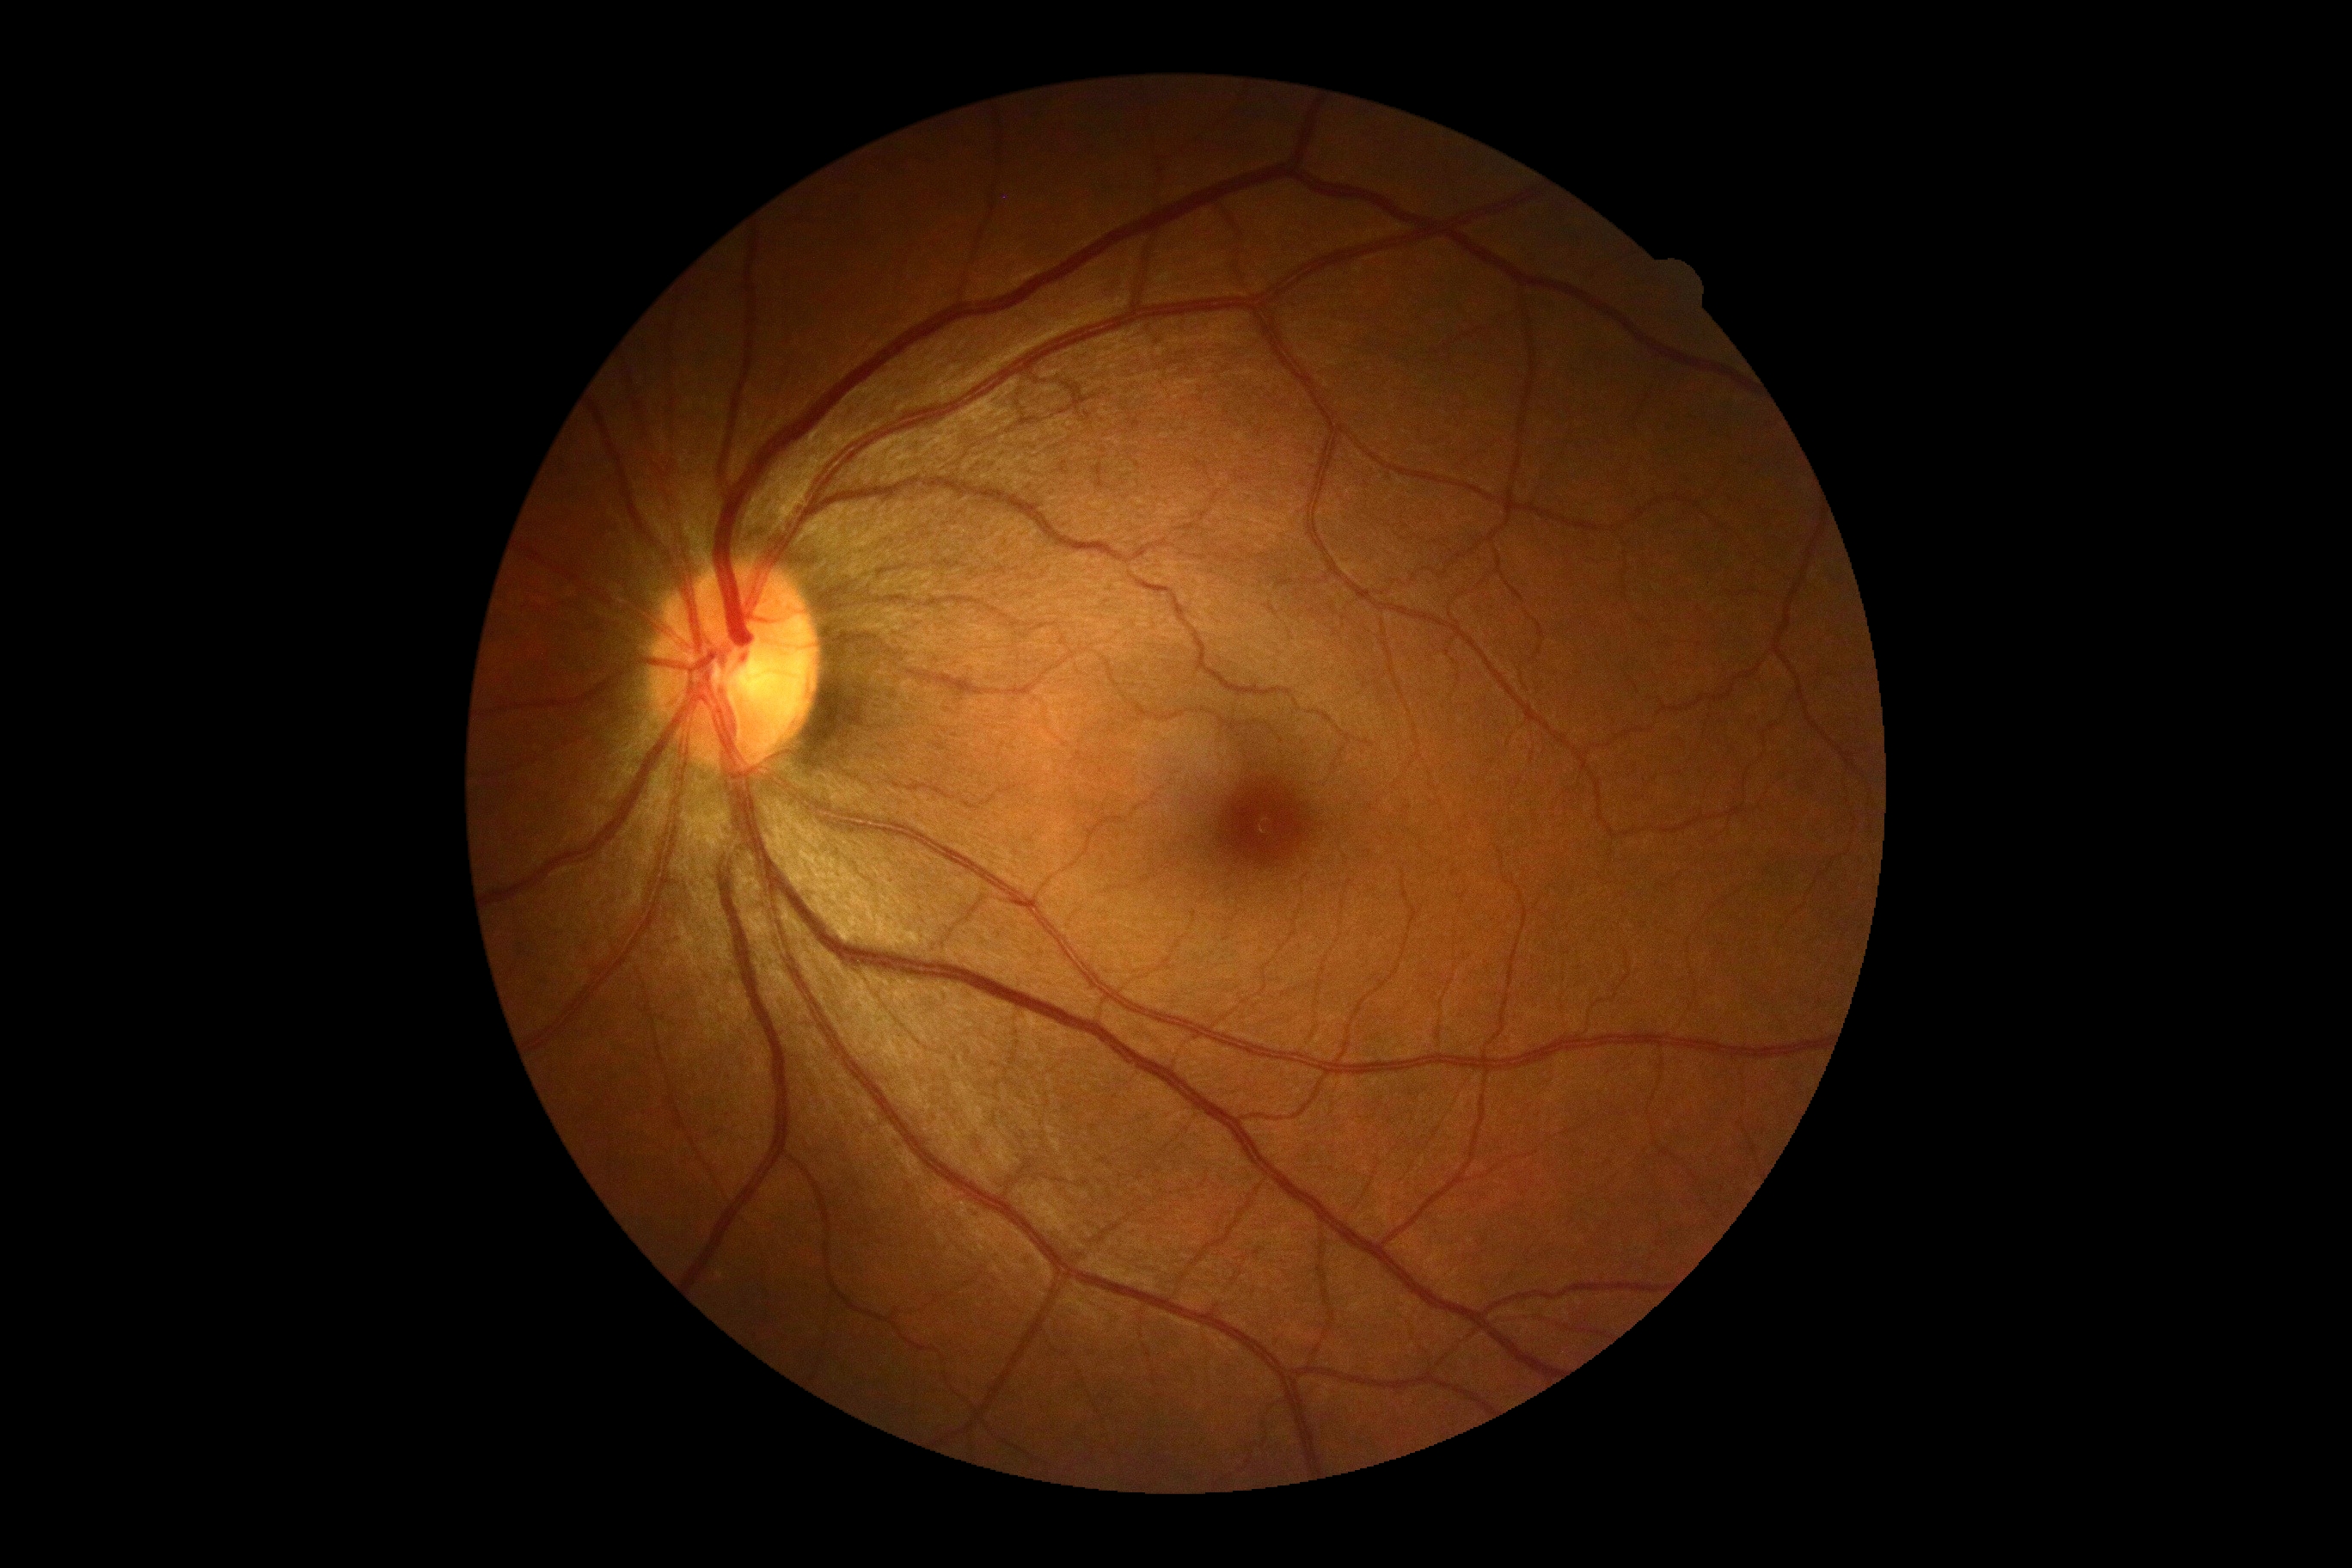 DR severity: grade 0 (no apparent retinopathy).